Color fundus photograph:
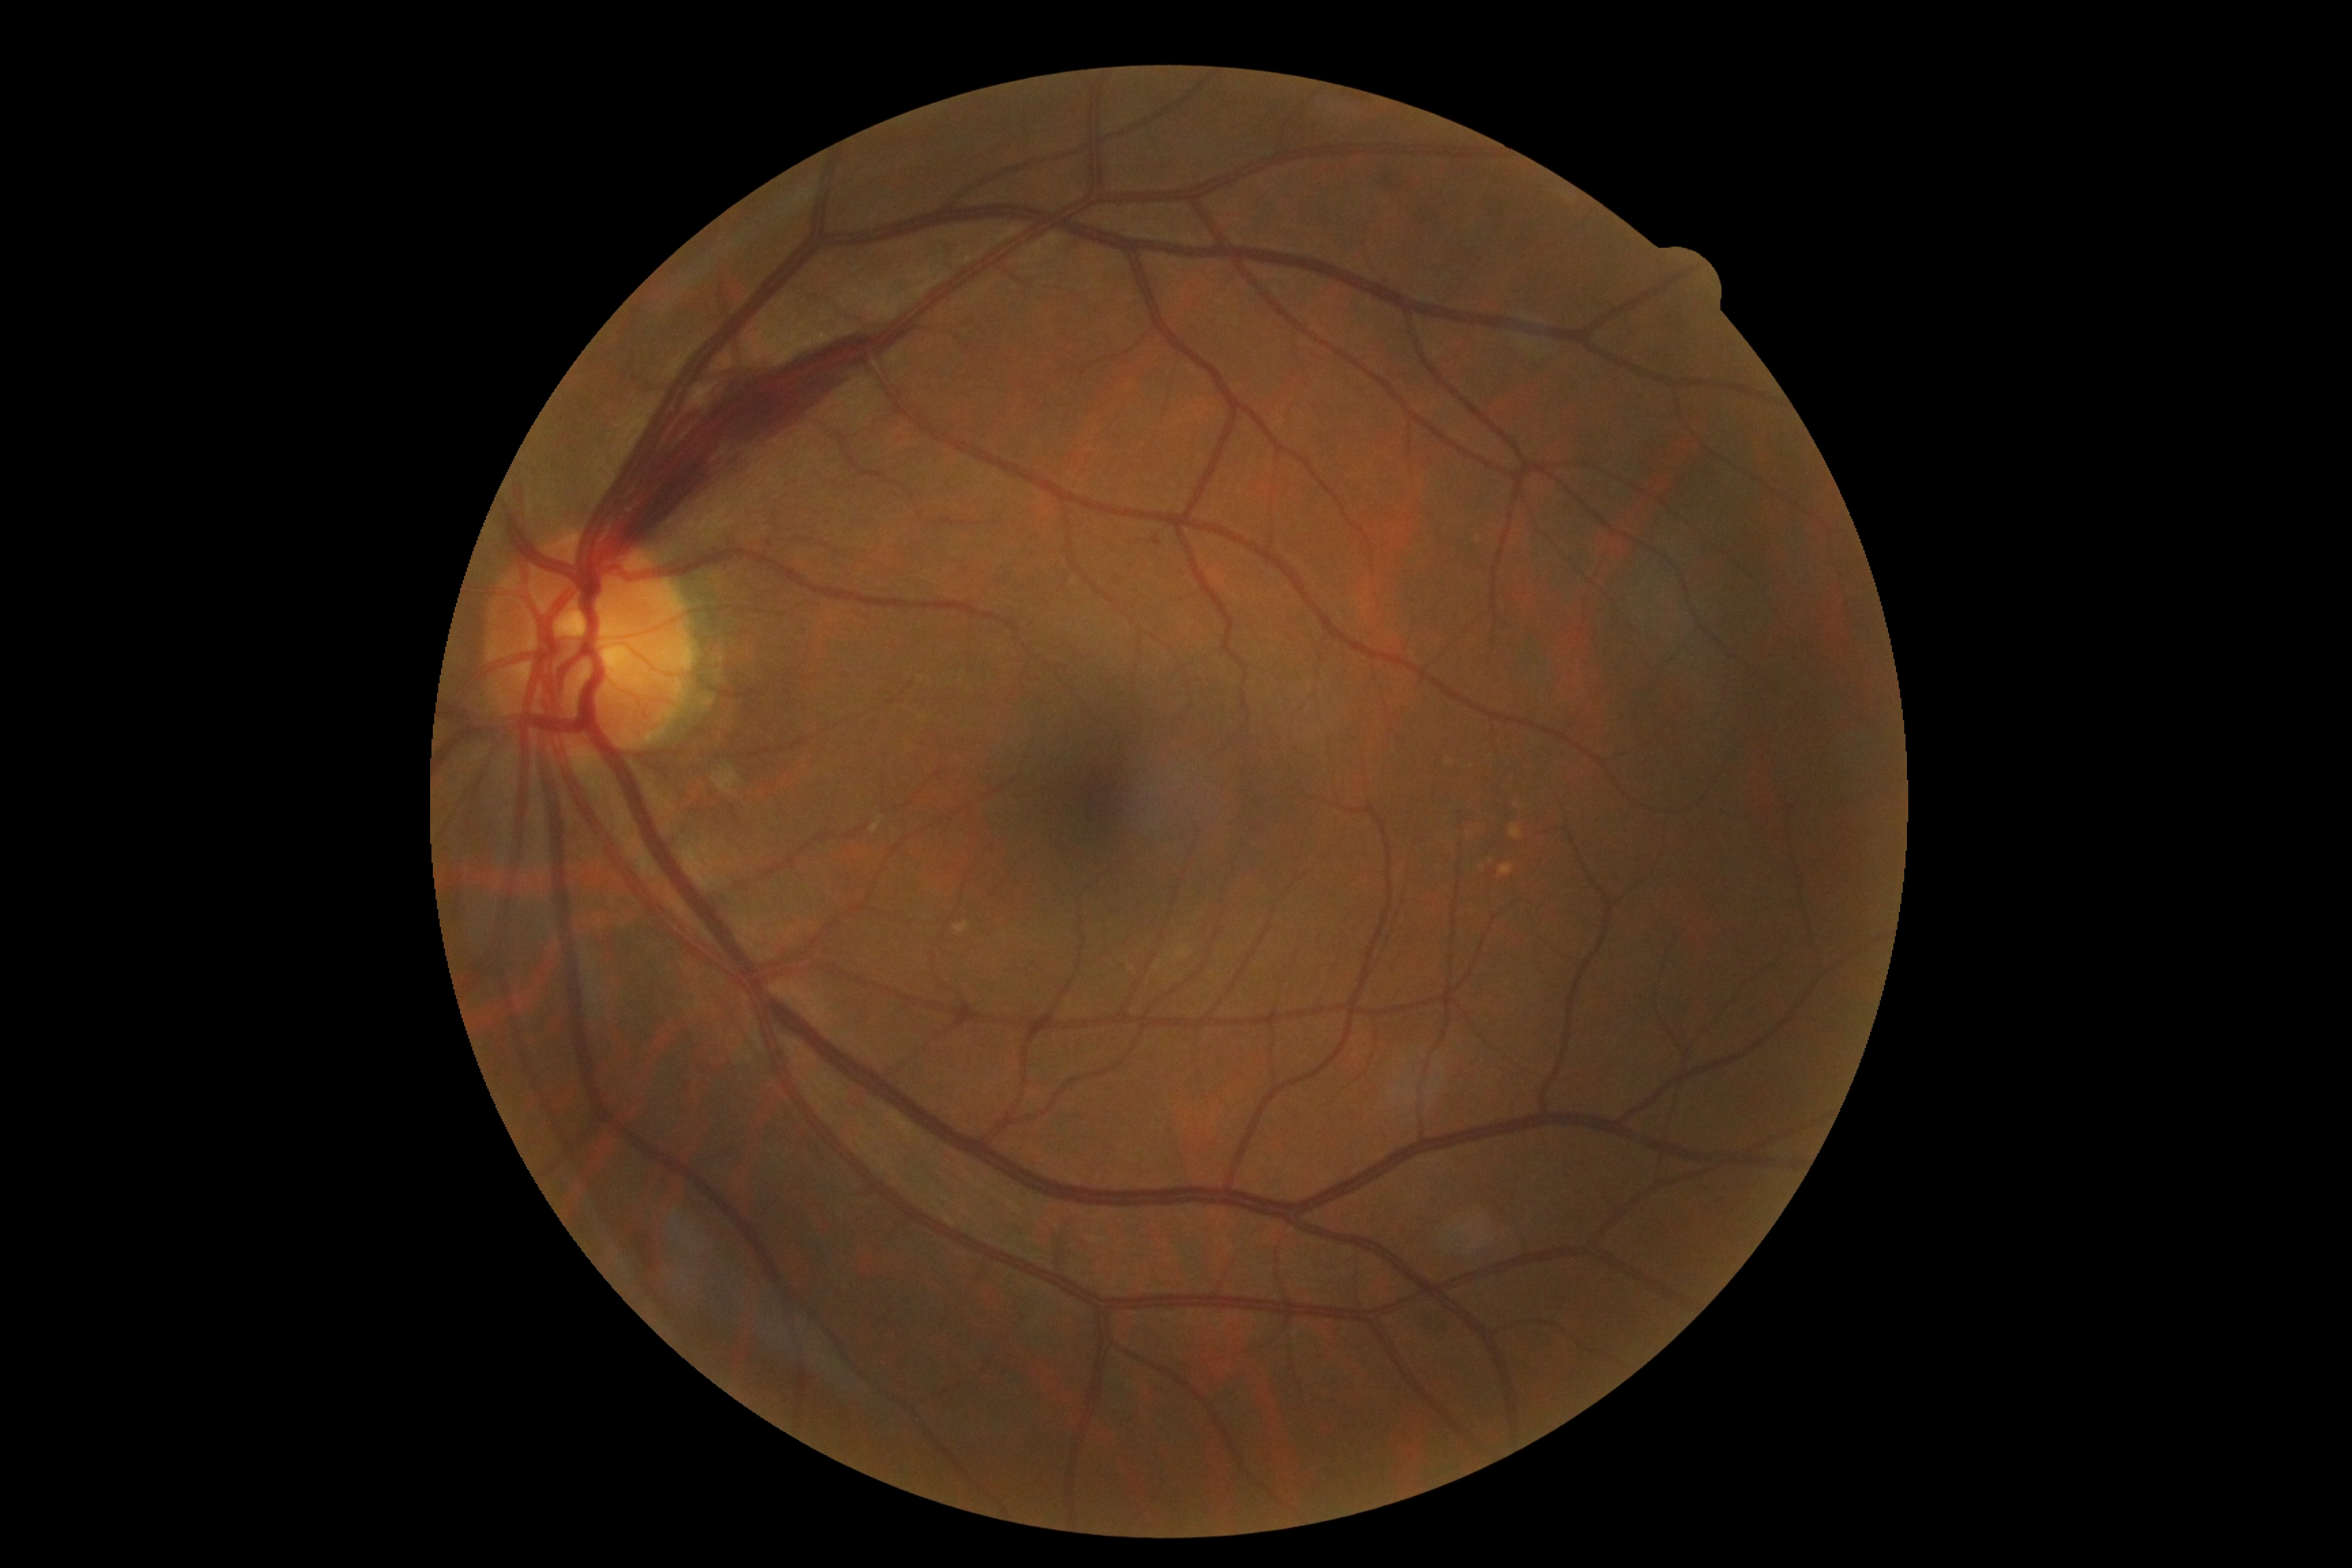 DR class: non-proliferative diabetic retinopathy.
Diabetic retinopathy (DR): grade 2.